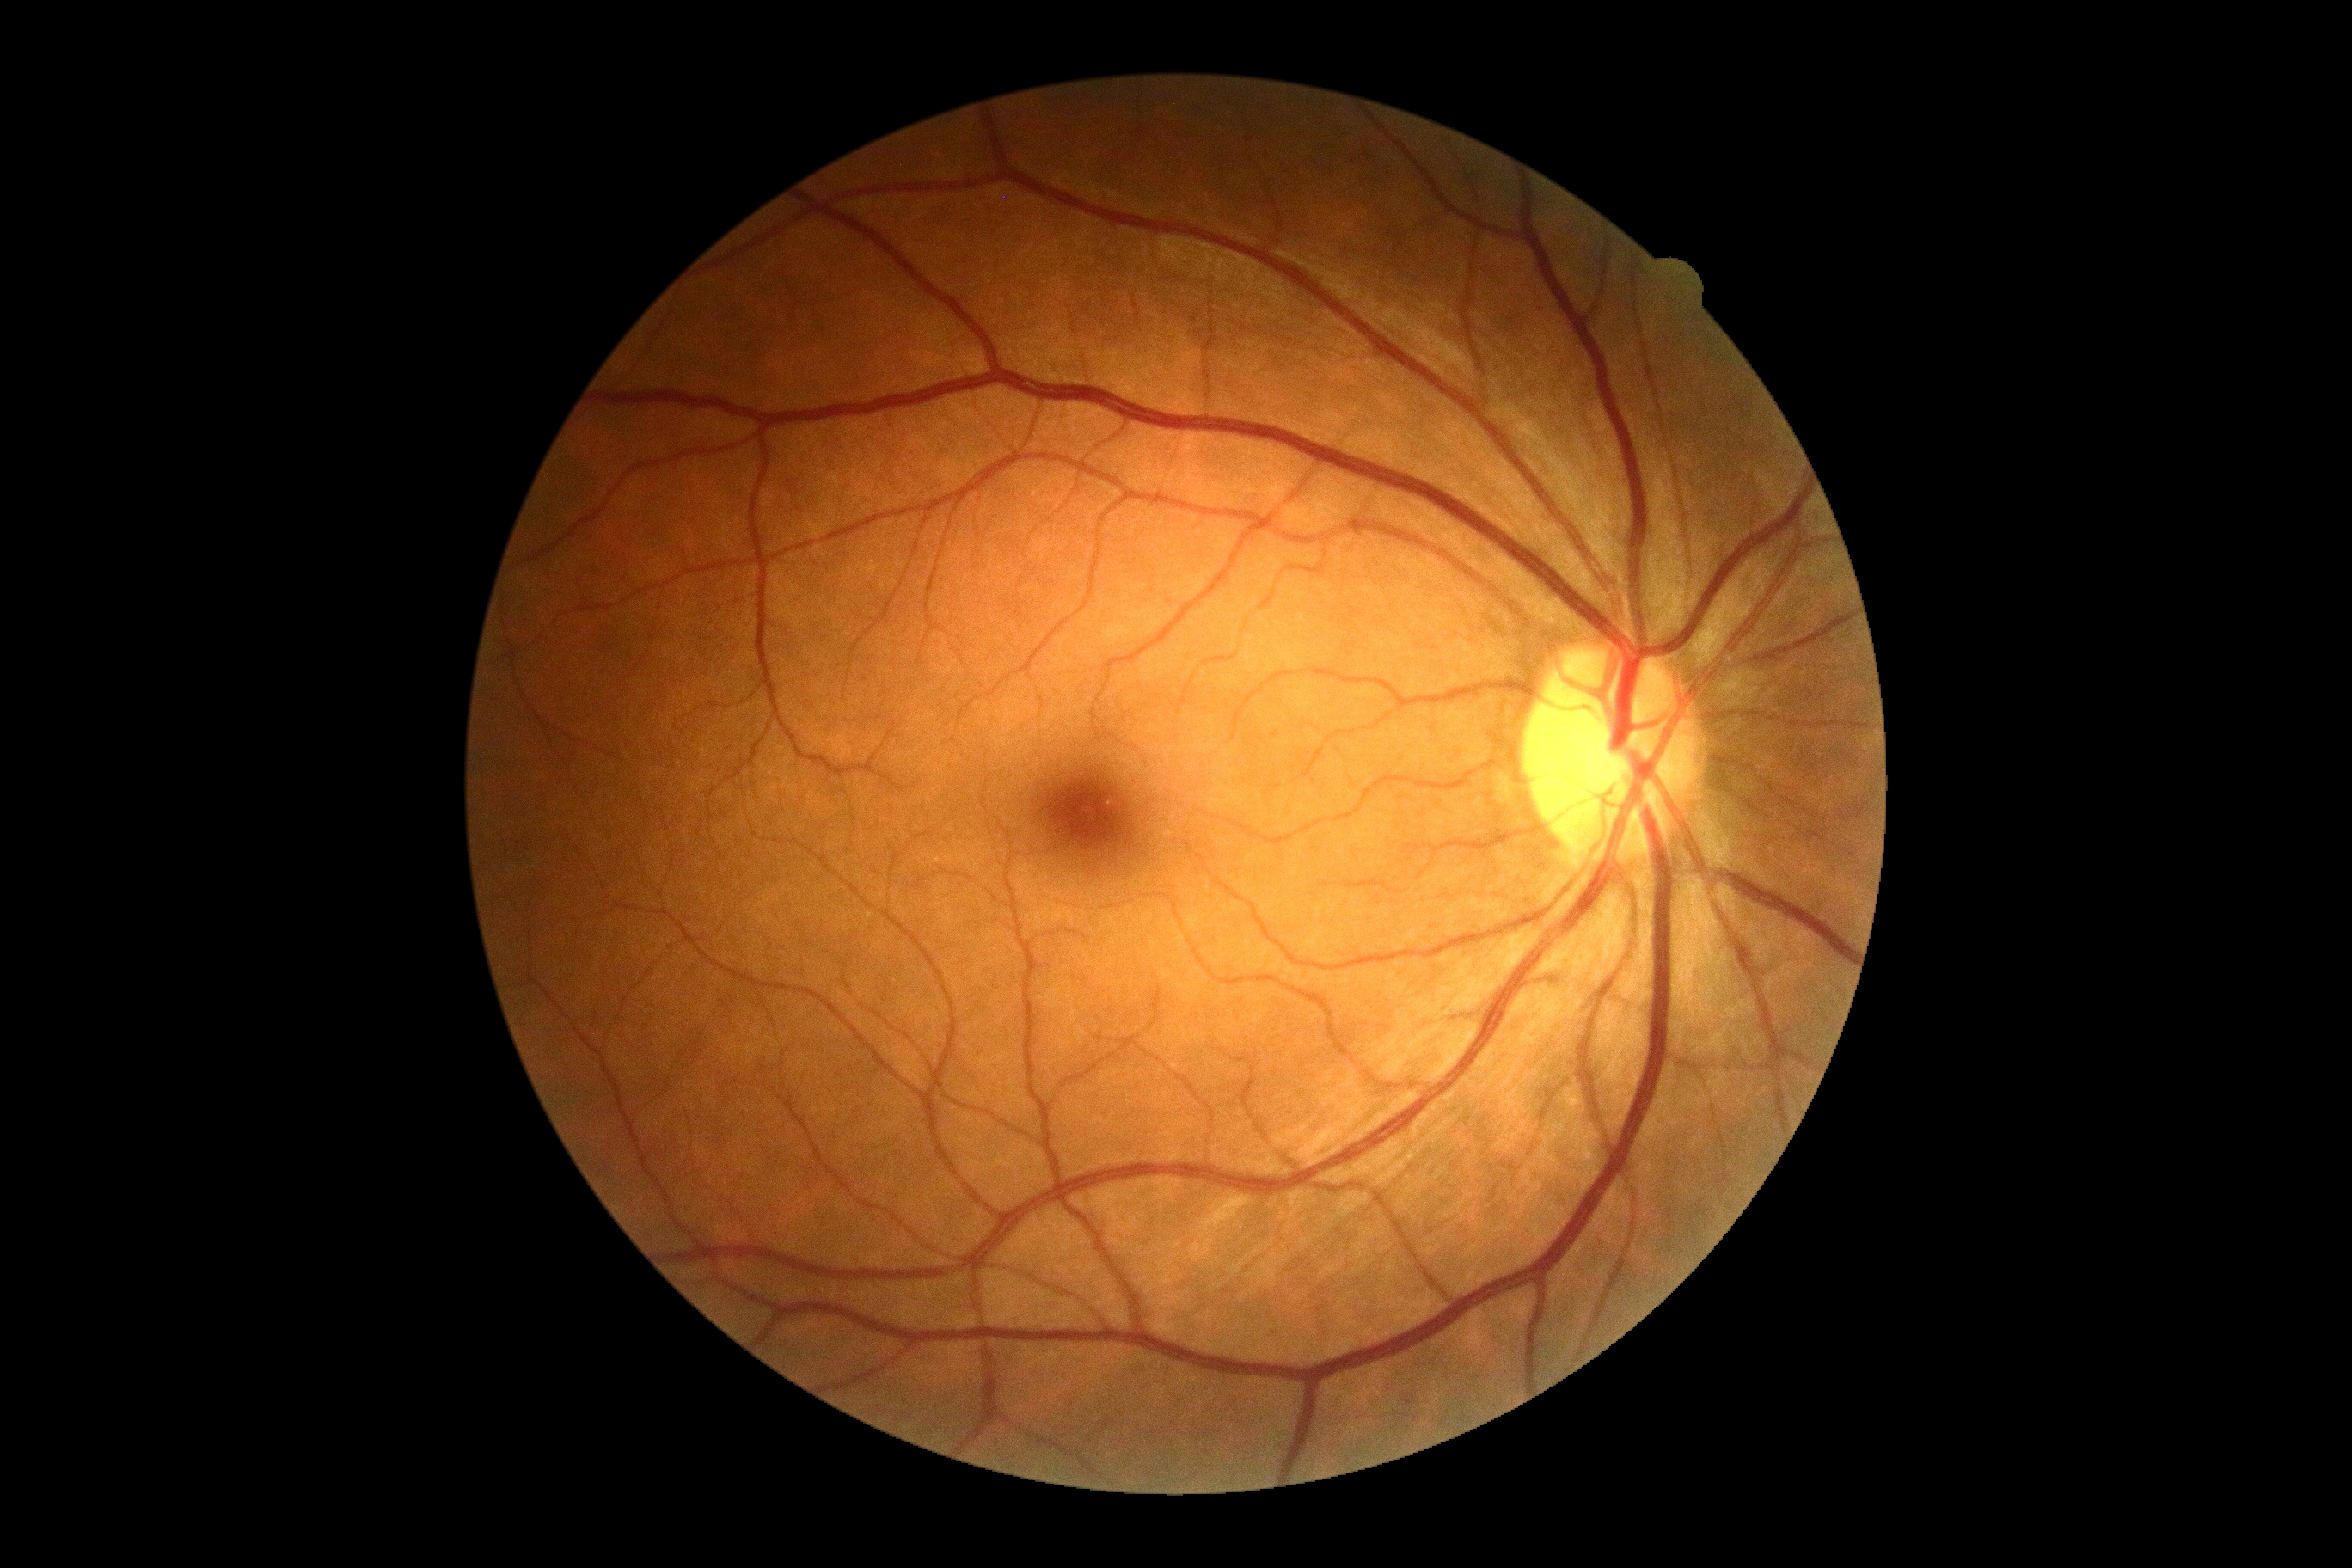

DR grade: no apparent retinopathy (0).